45° FOV
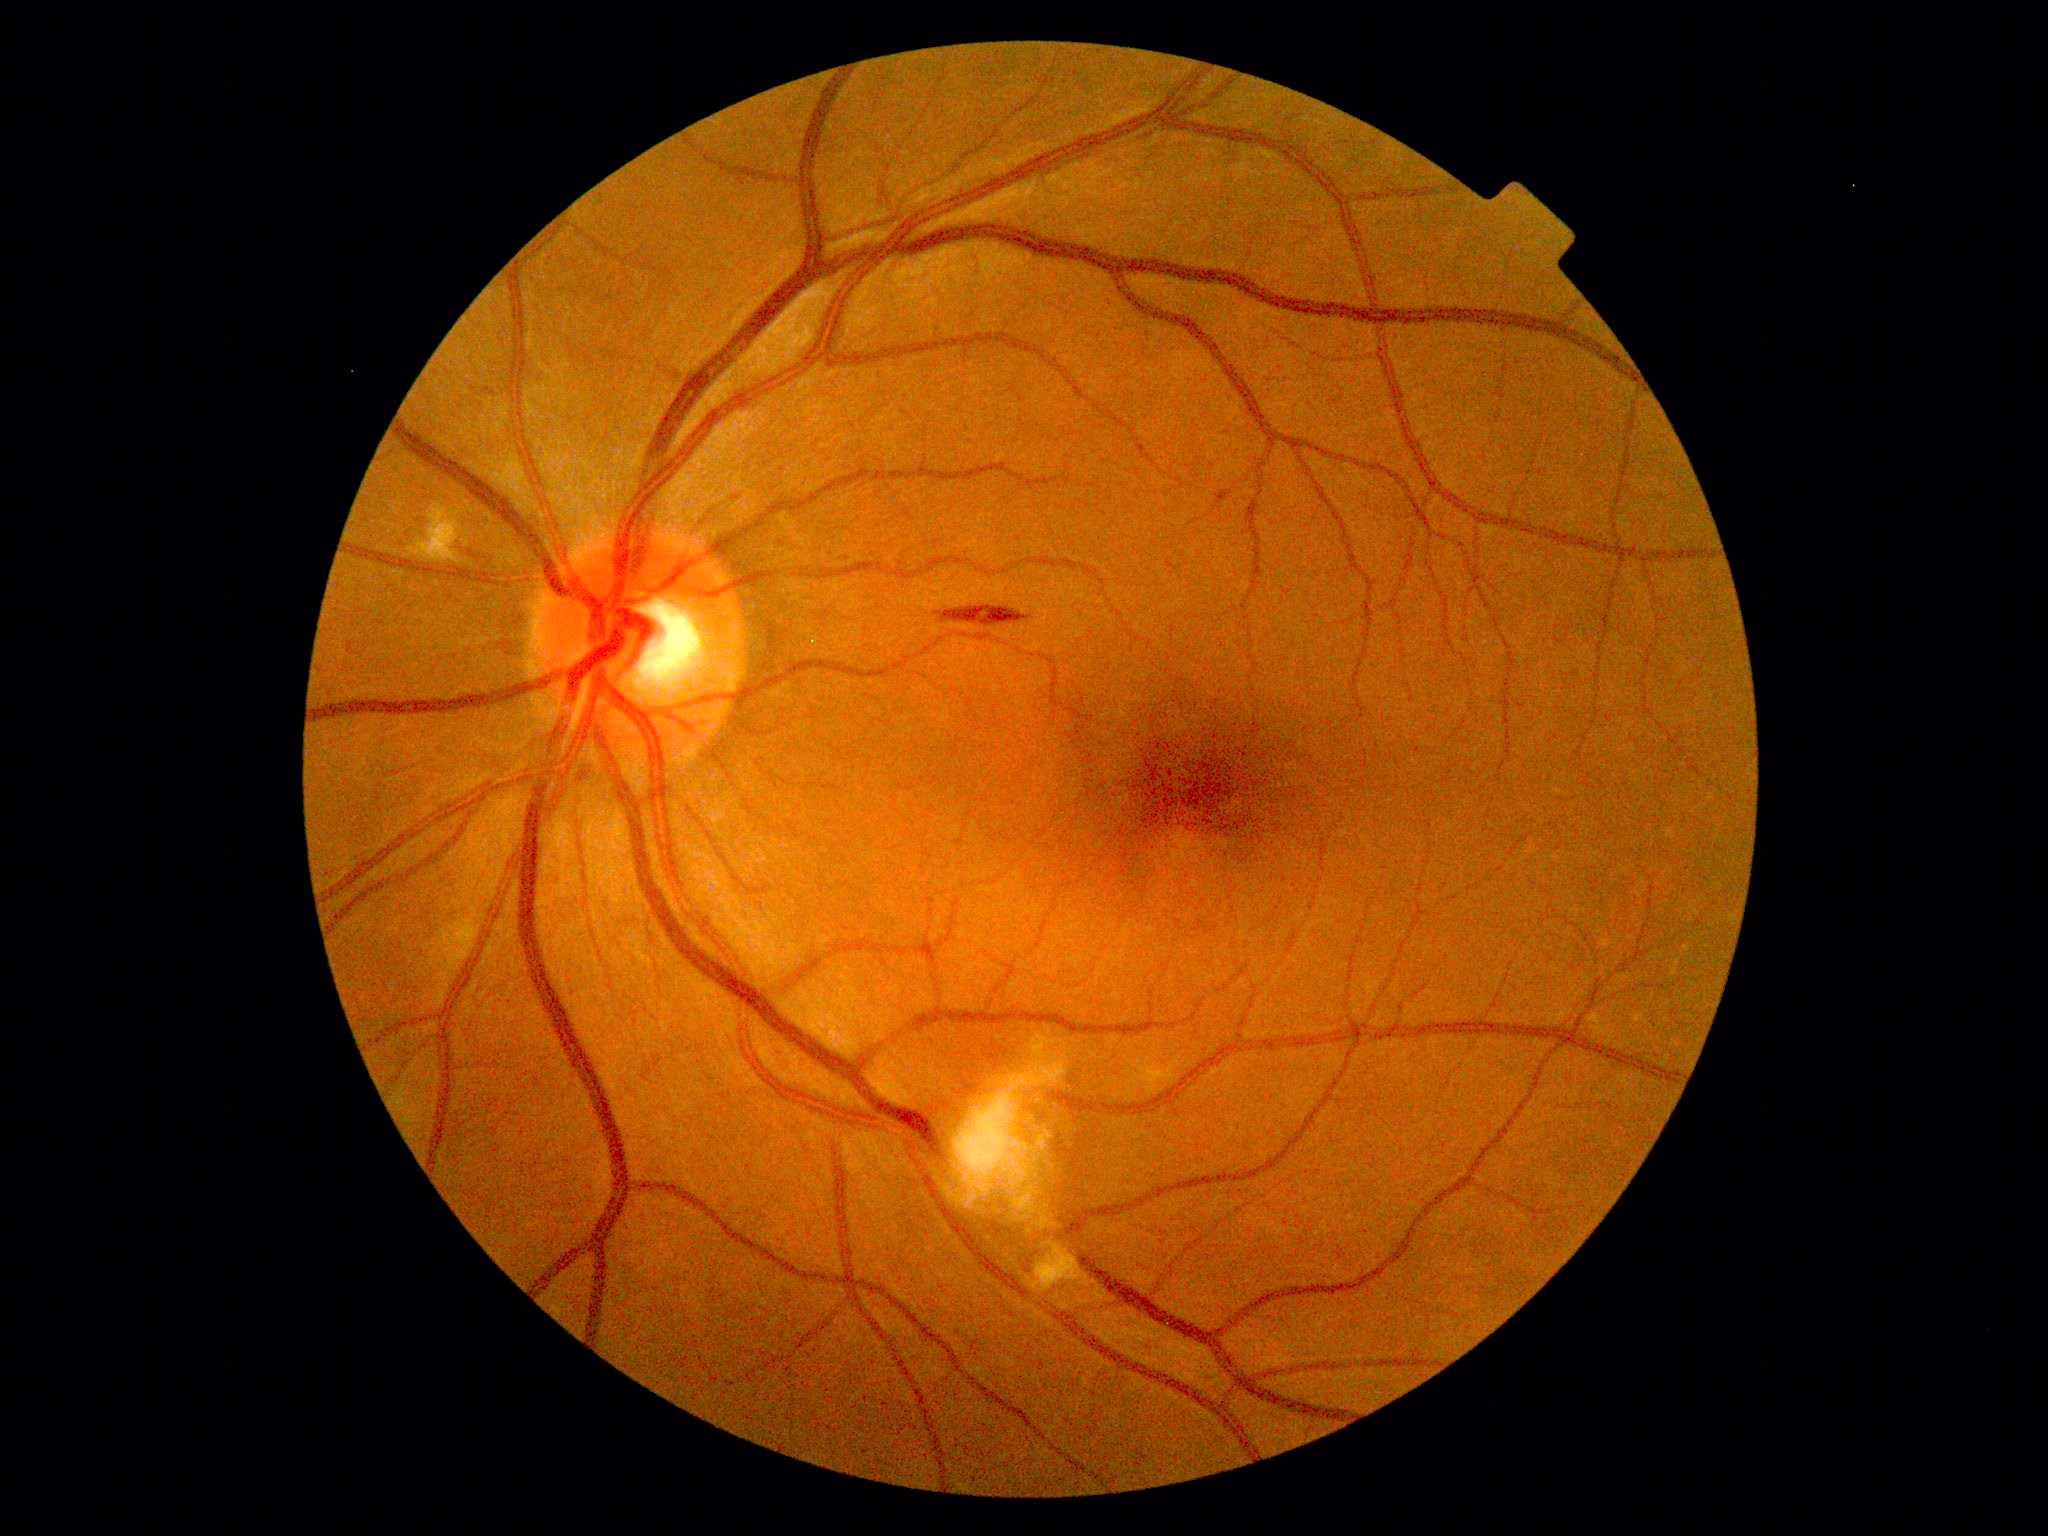 DR = grade 2 — more than just microaneurysms but less than severe NPDR.